45° FOV; image size 2048x1536: 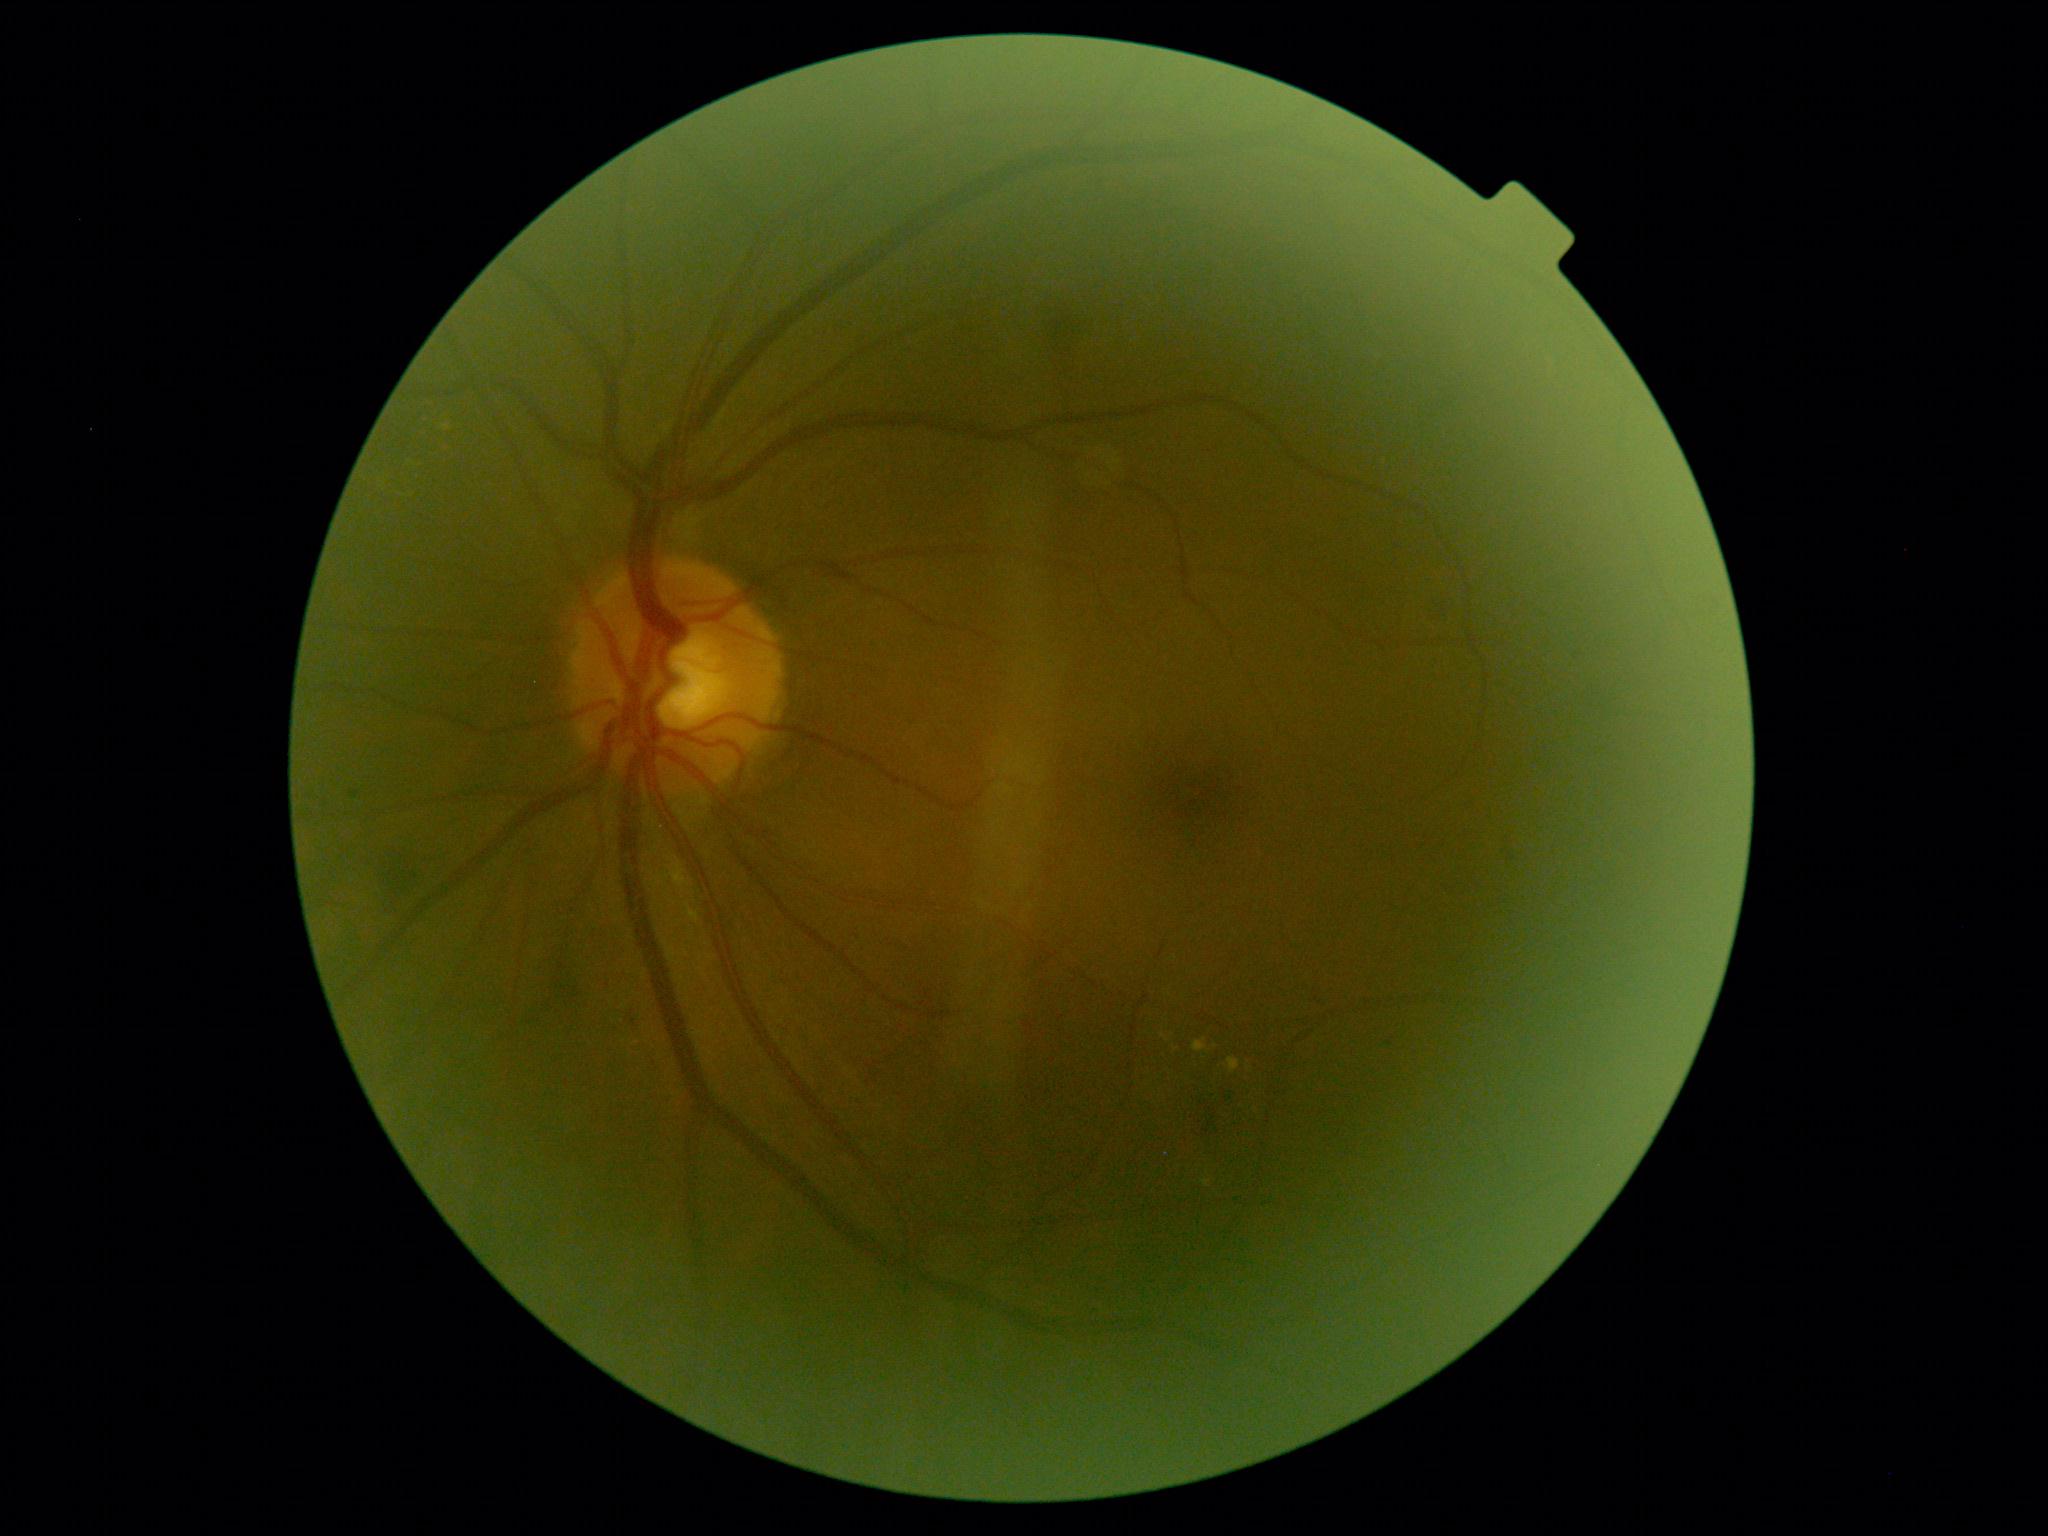
The retinopathy is classified as non-proliferative diabetic retinopathy.
Diabetic retinopathy severity is moderate non-proliferative diabetic retinopathy (grade 2).